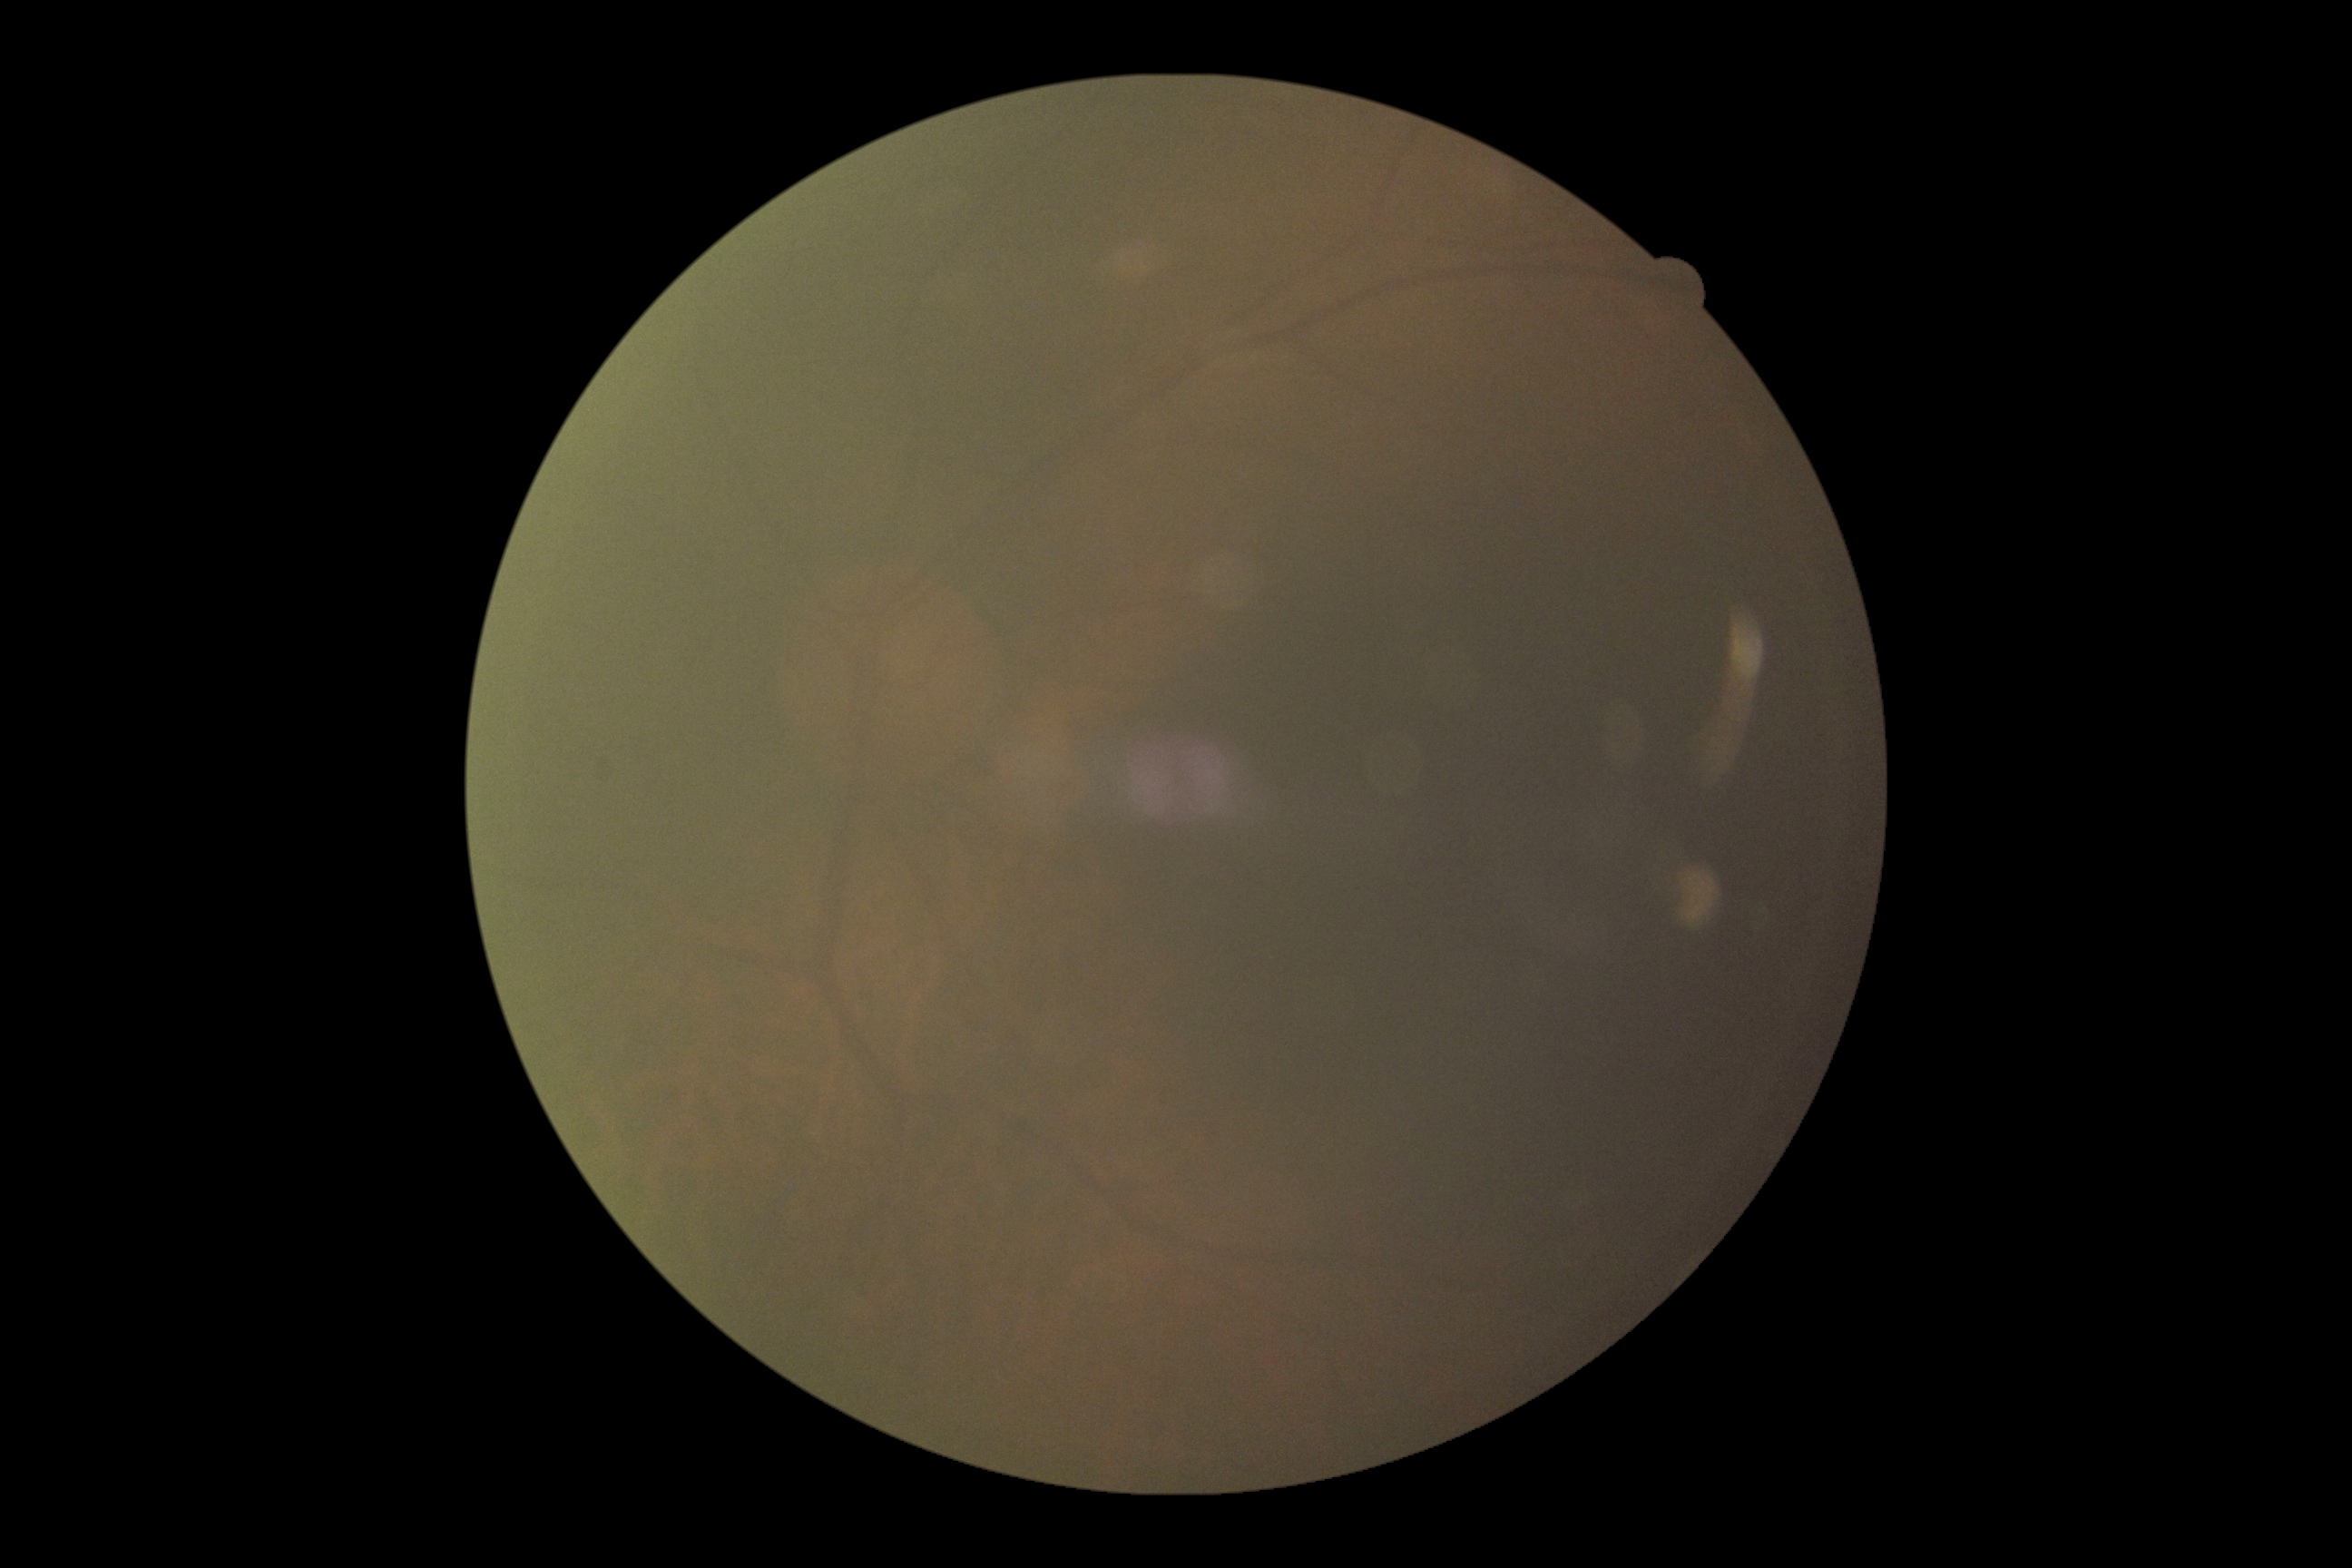 retinopathy: ungradable, image quality: insufficient for DR assessment.